Color fundus image; FOV: 45 degrees — 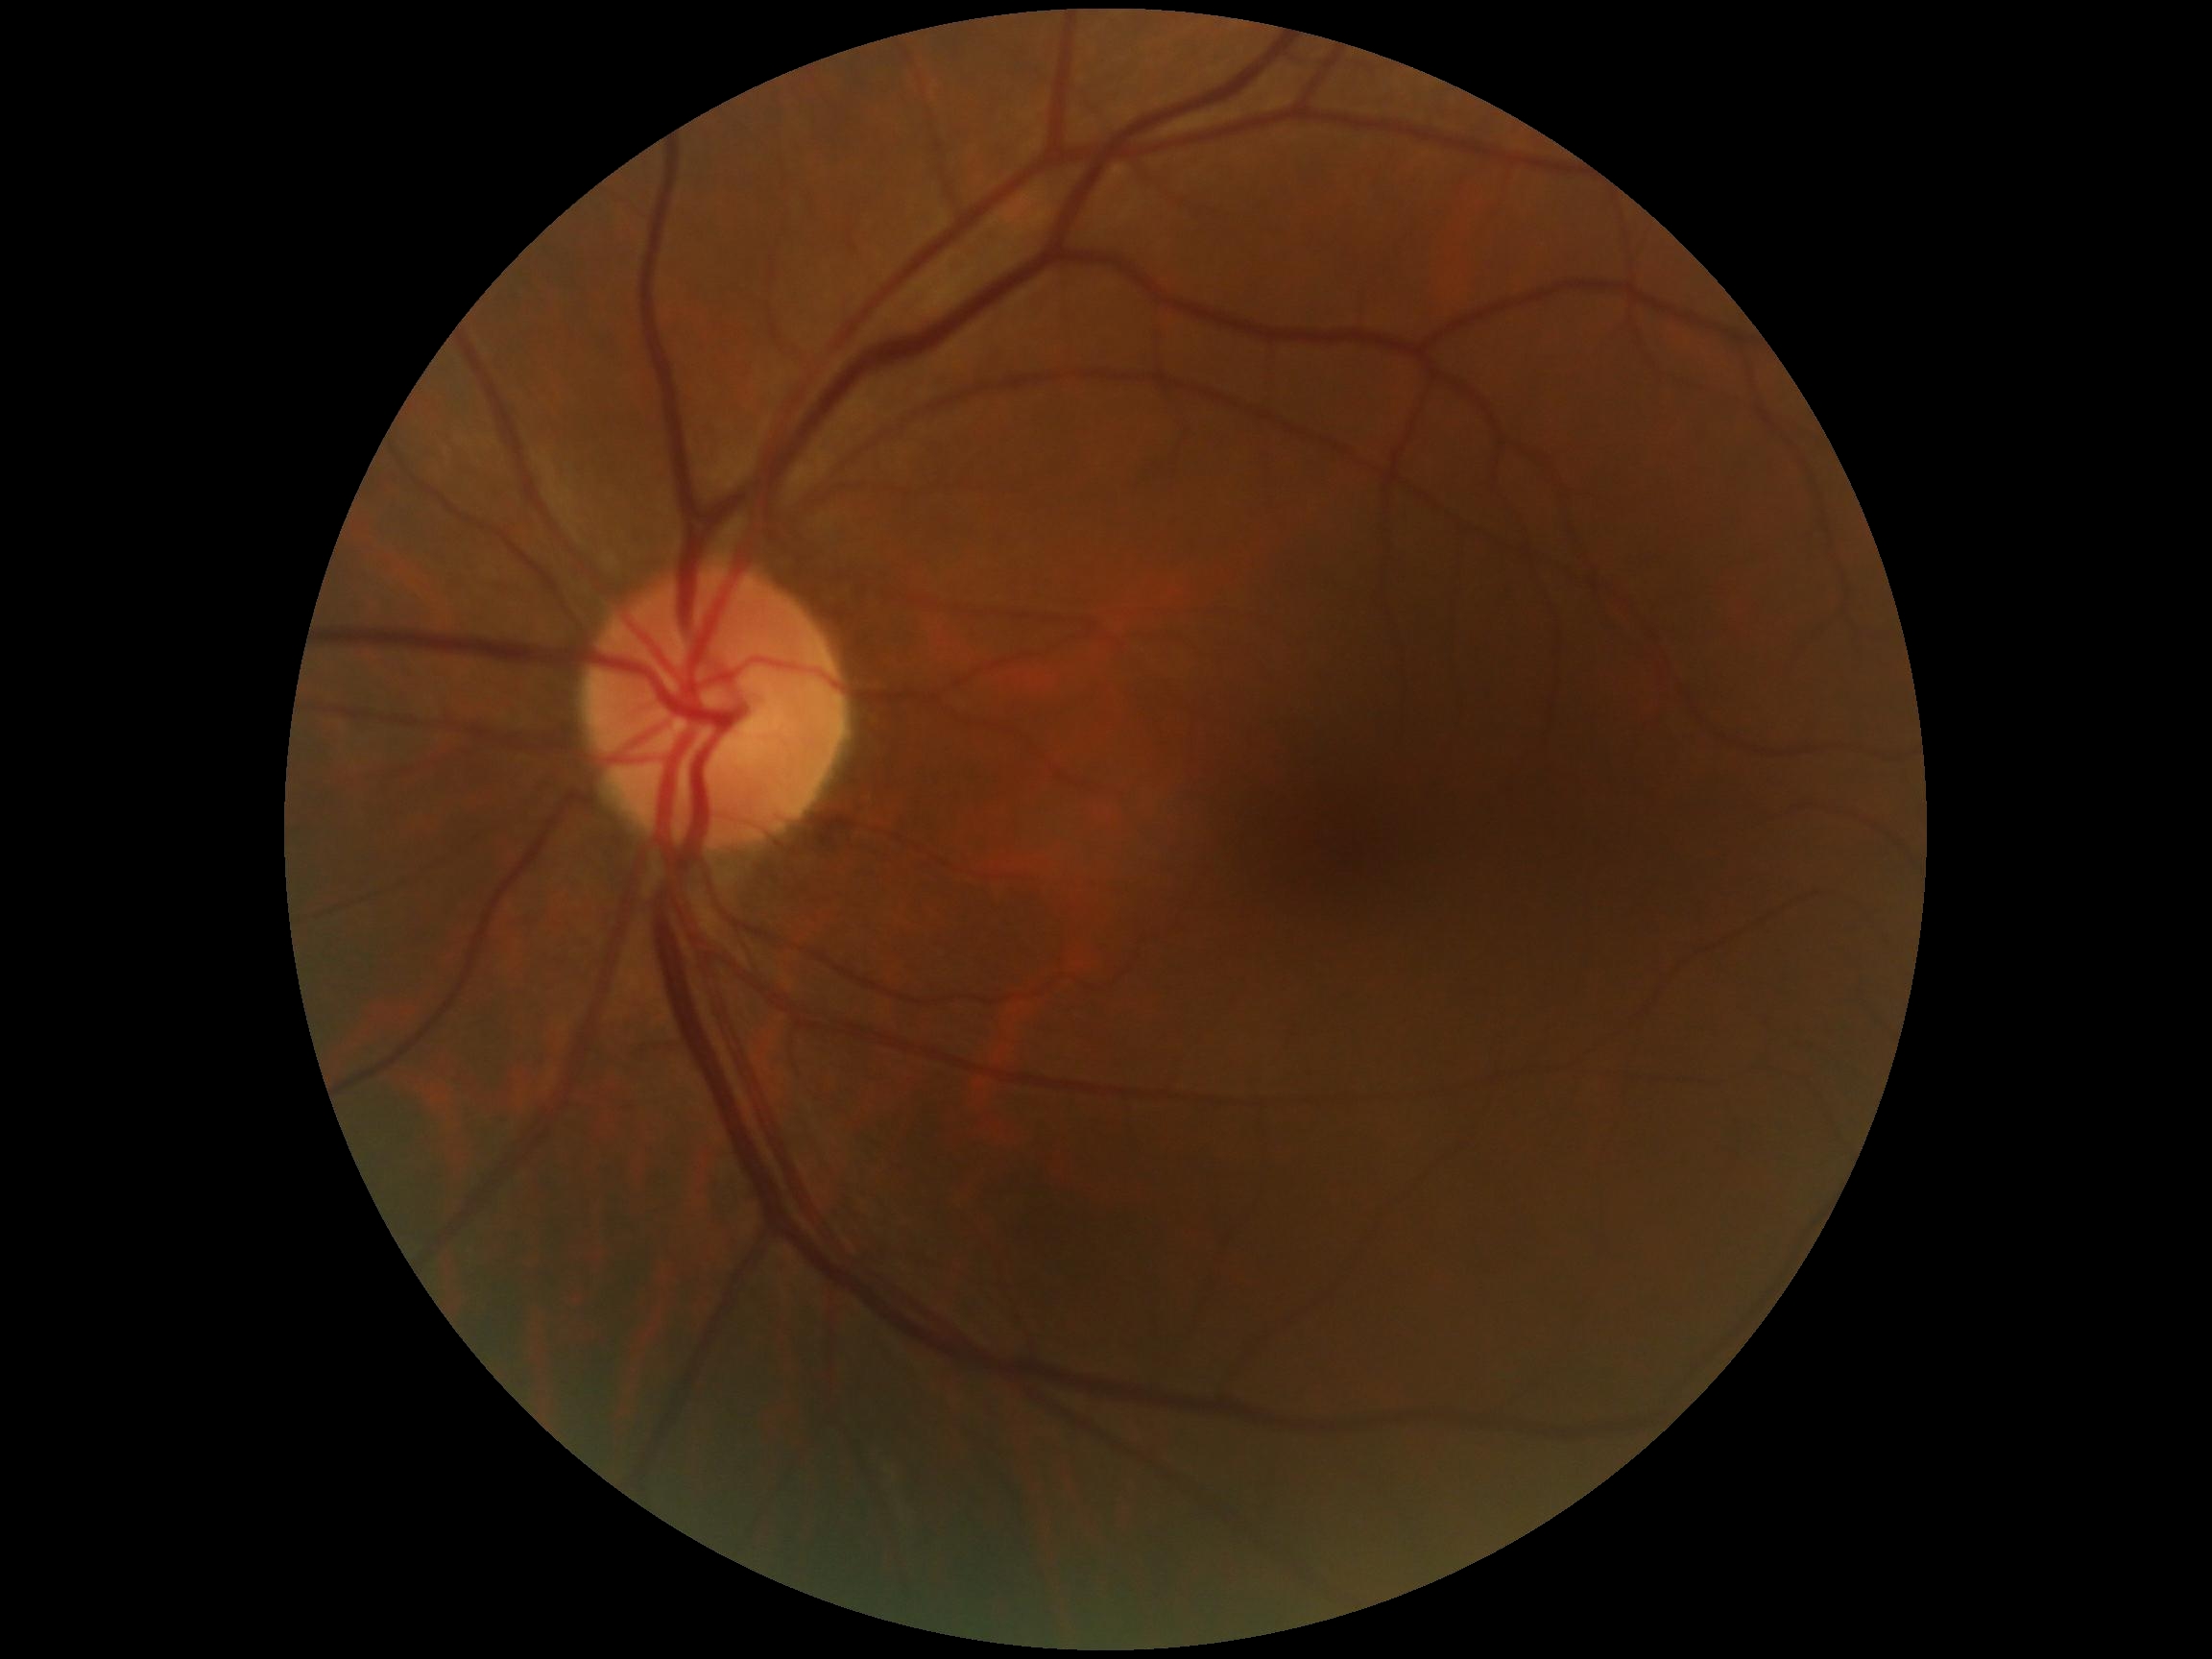 No apparent diabetic retinopathy.
Retinopathy grade is 0 — no visible signs of diabetic retinopathy.